2352 by 1568 pixels · retinal fundus photograph.
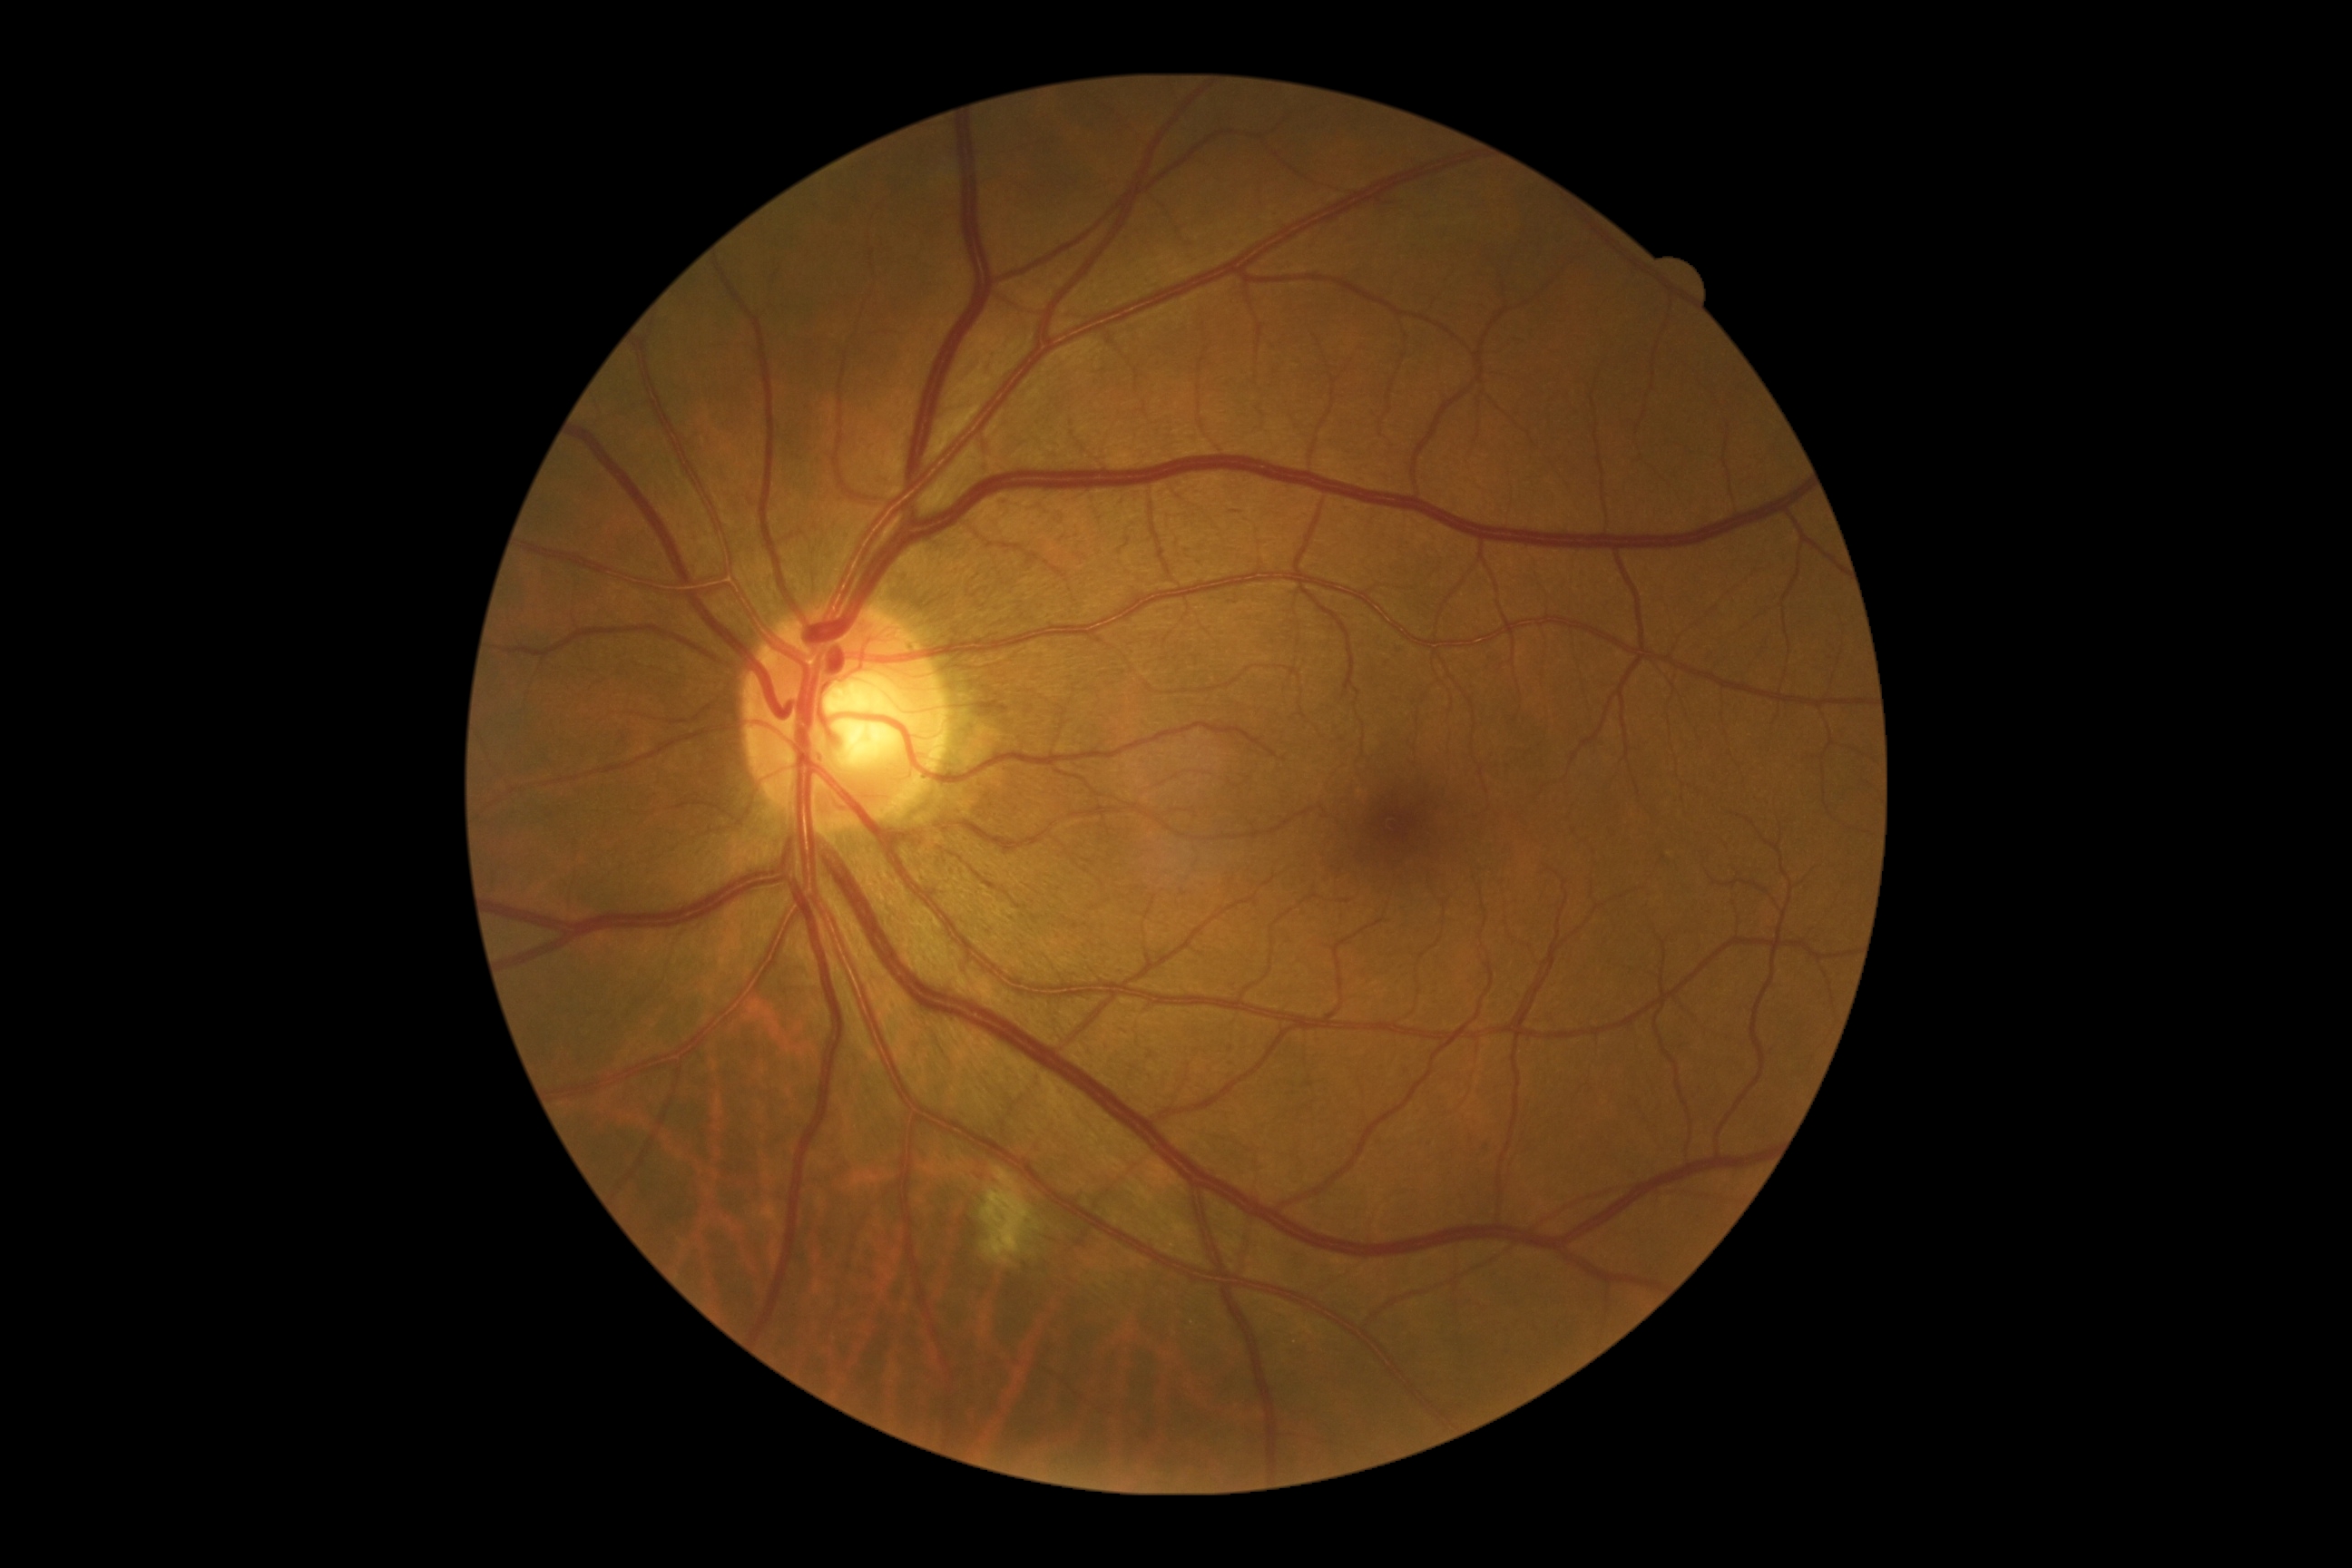
Diabetic retinopathy: moderate non-proliferative diabetic retinopathy (grade 2) — more than just microaneurysms but less than severe NPDR.